45-degree field of view: 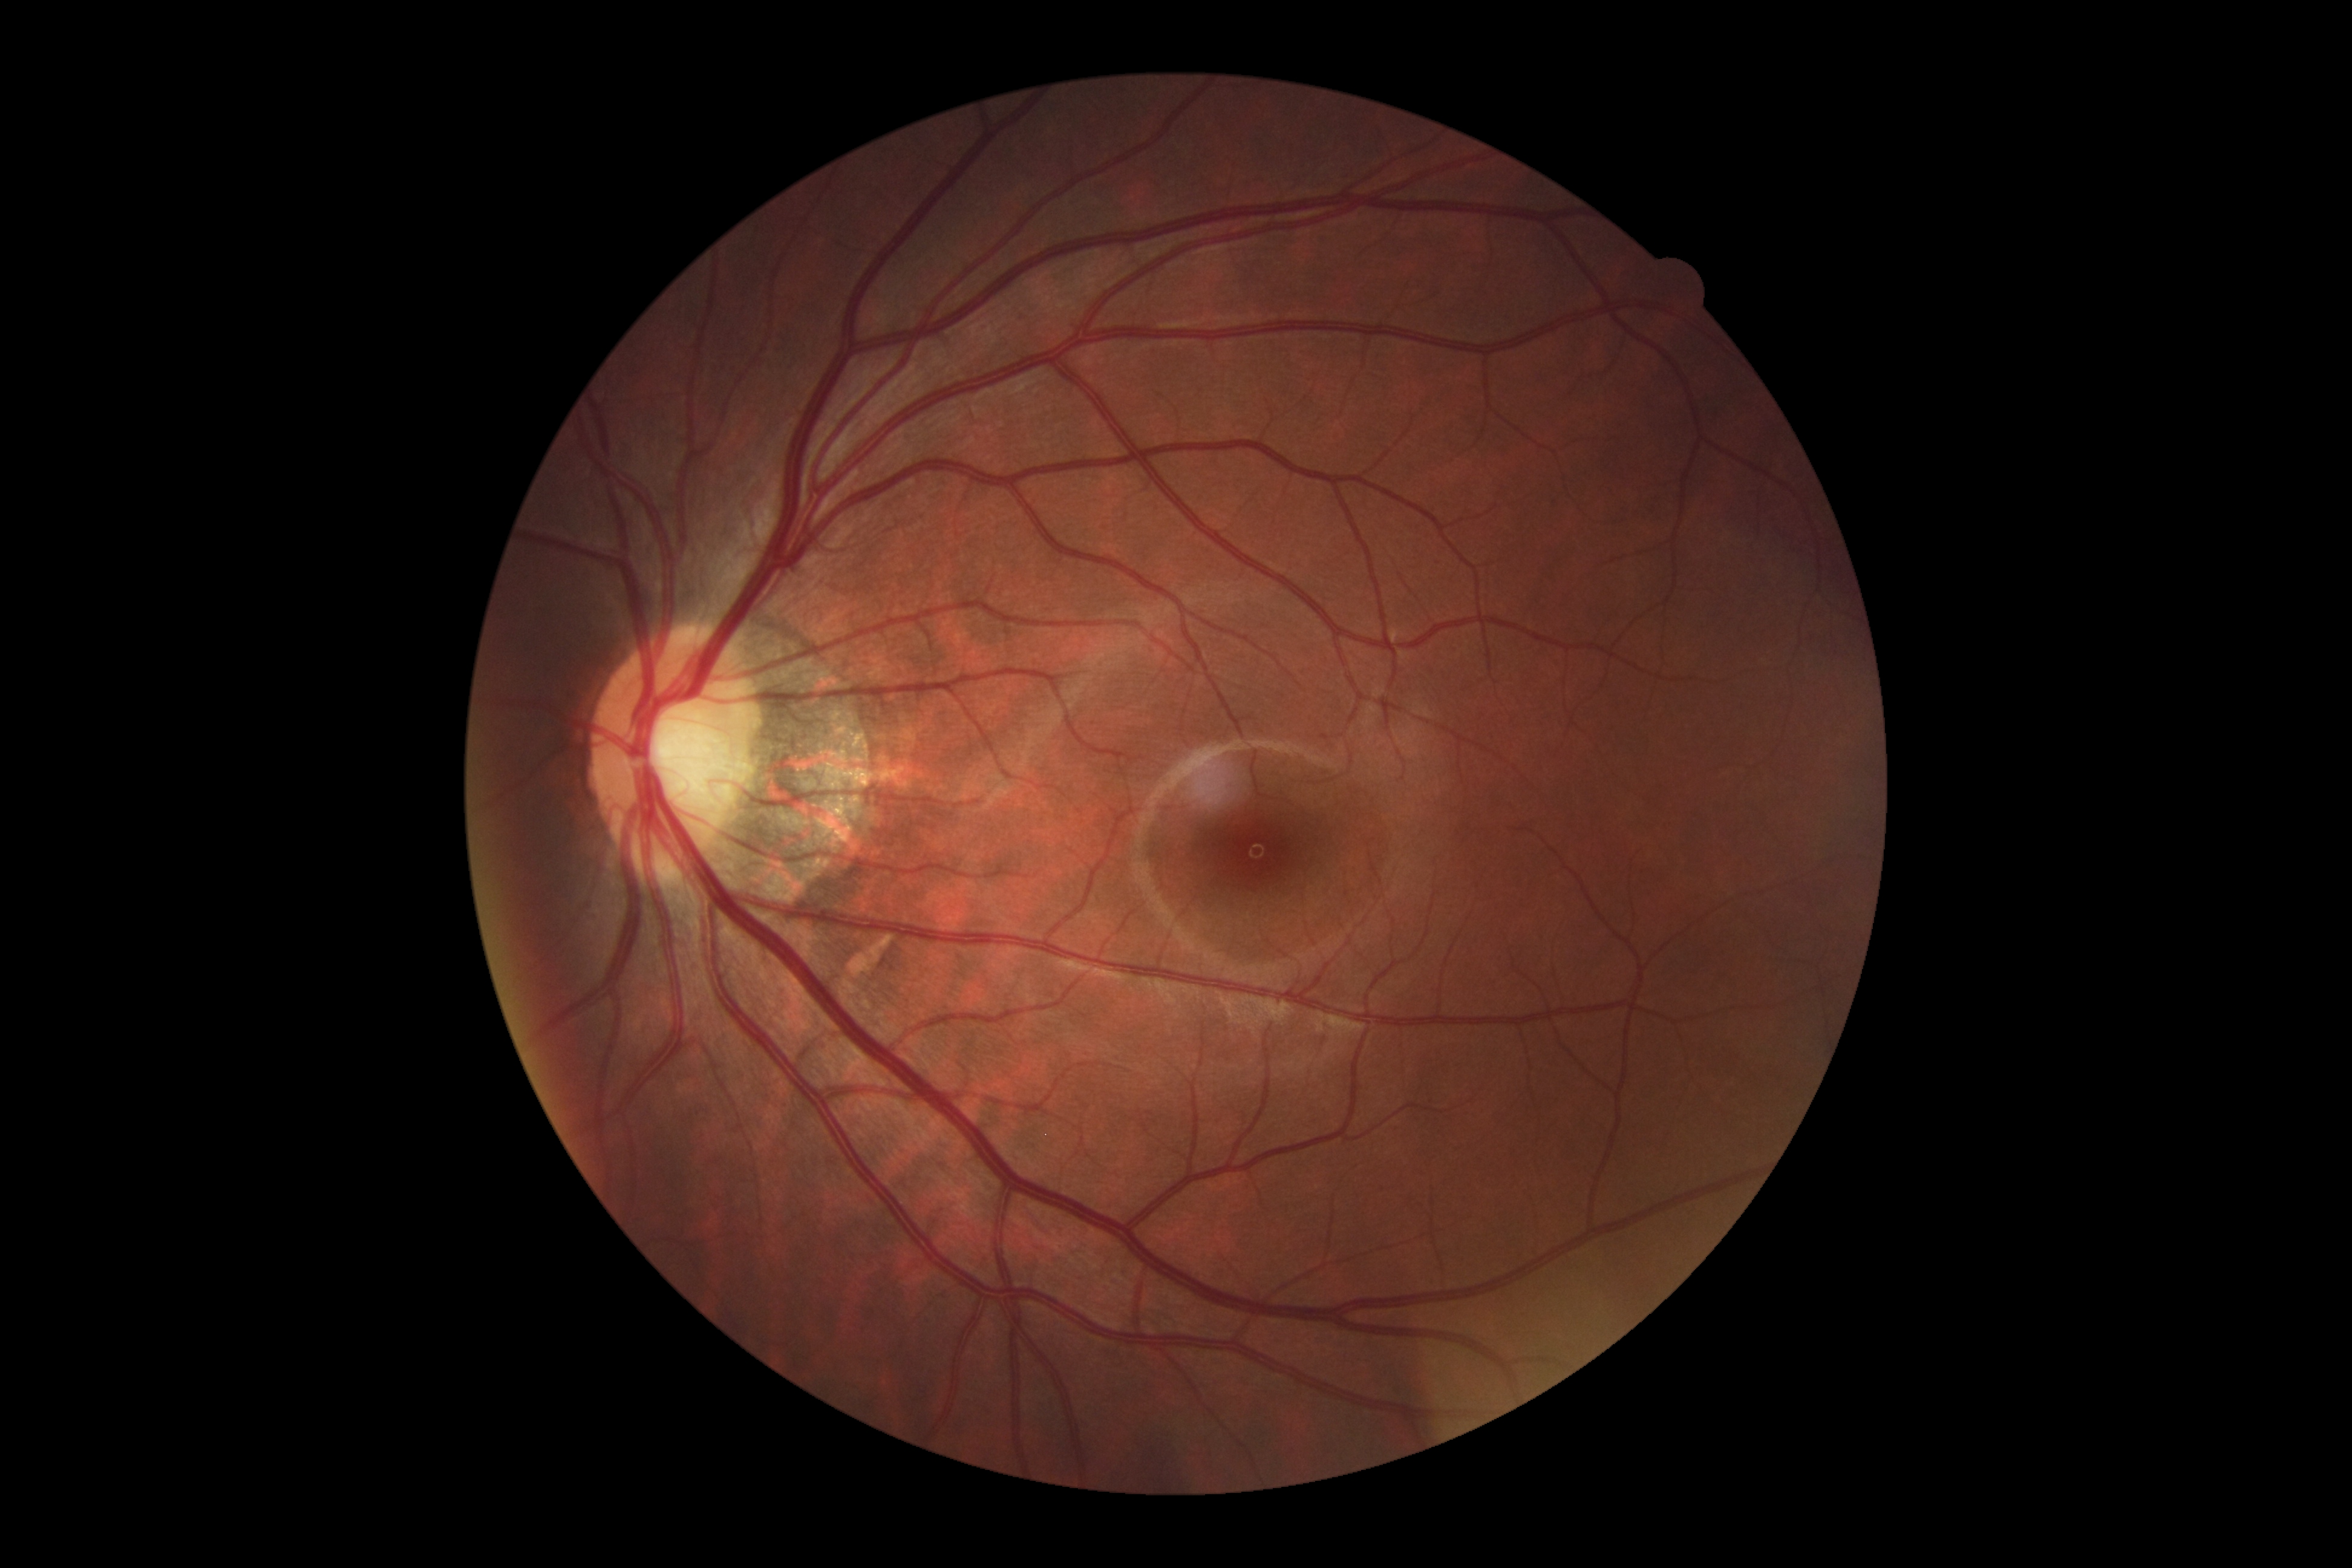

Diabetic retinopathy (DR) is grade 0 (no apparent retinopathy) — no visible signs of diabetic retinopathy. No diabetic retinal disease findings.